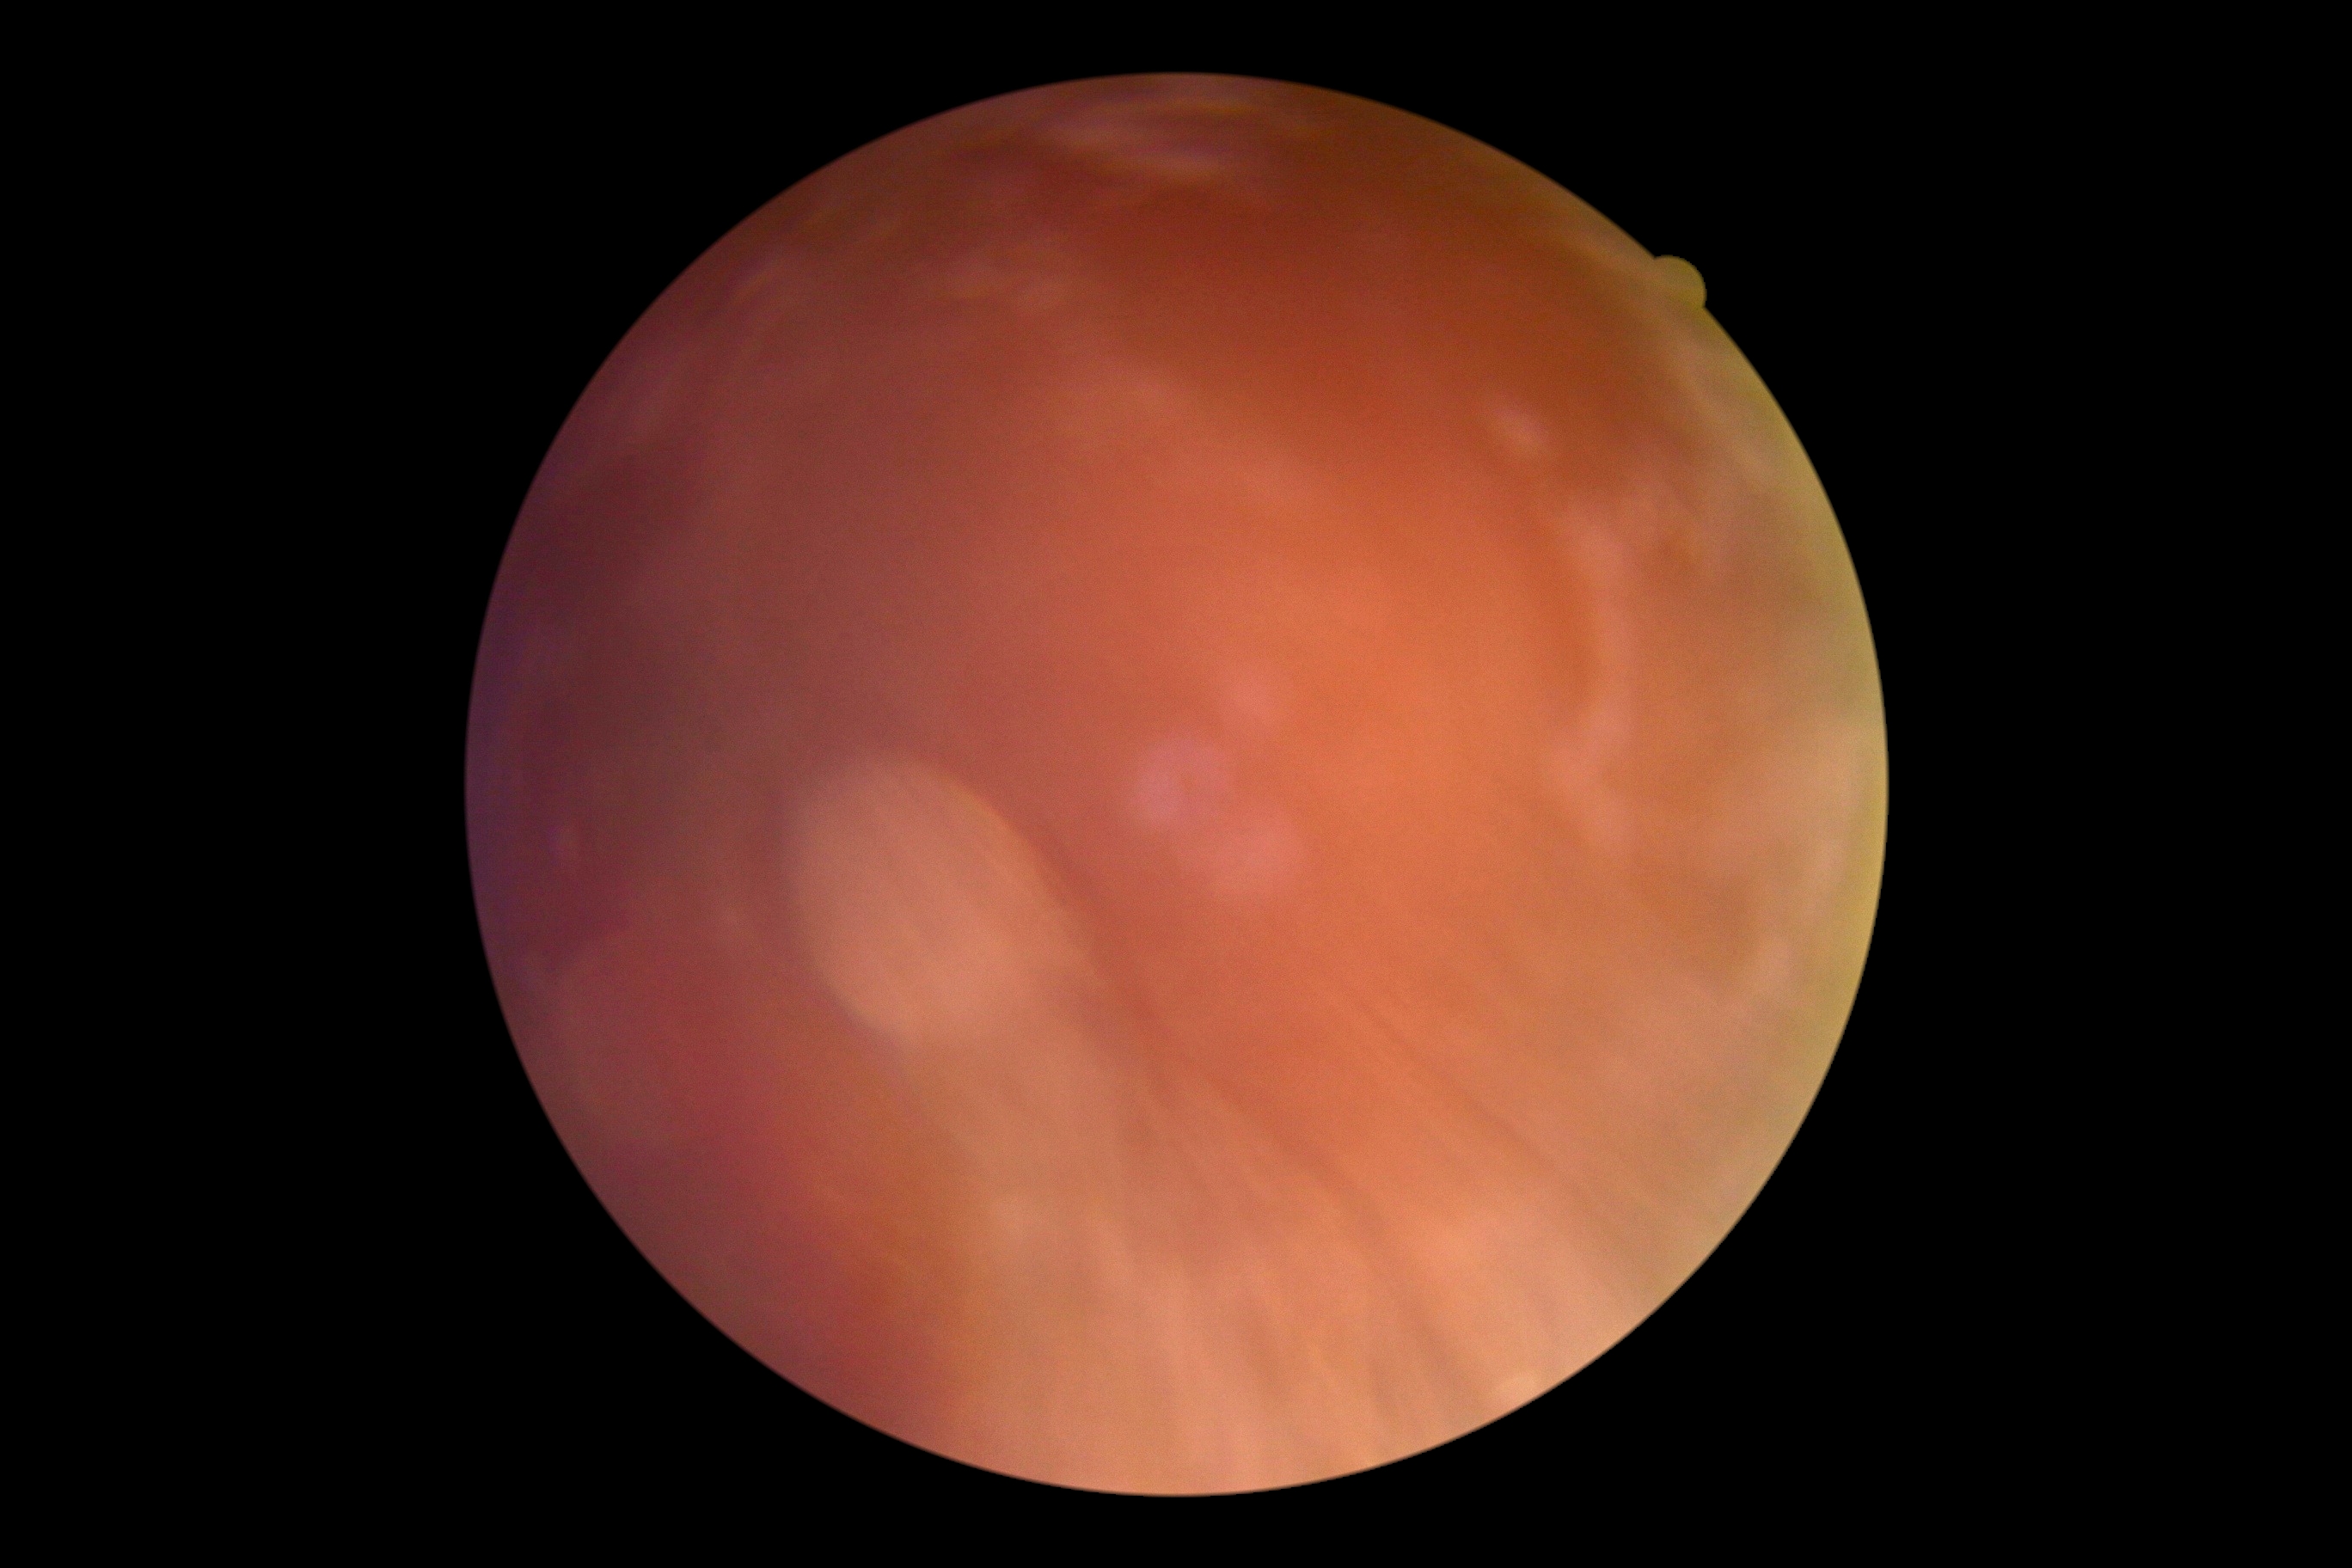

DR: ungradable.